1932 x 1932 pixels; Topcon TRC-NW8
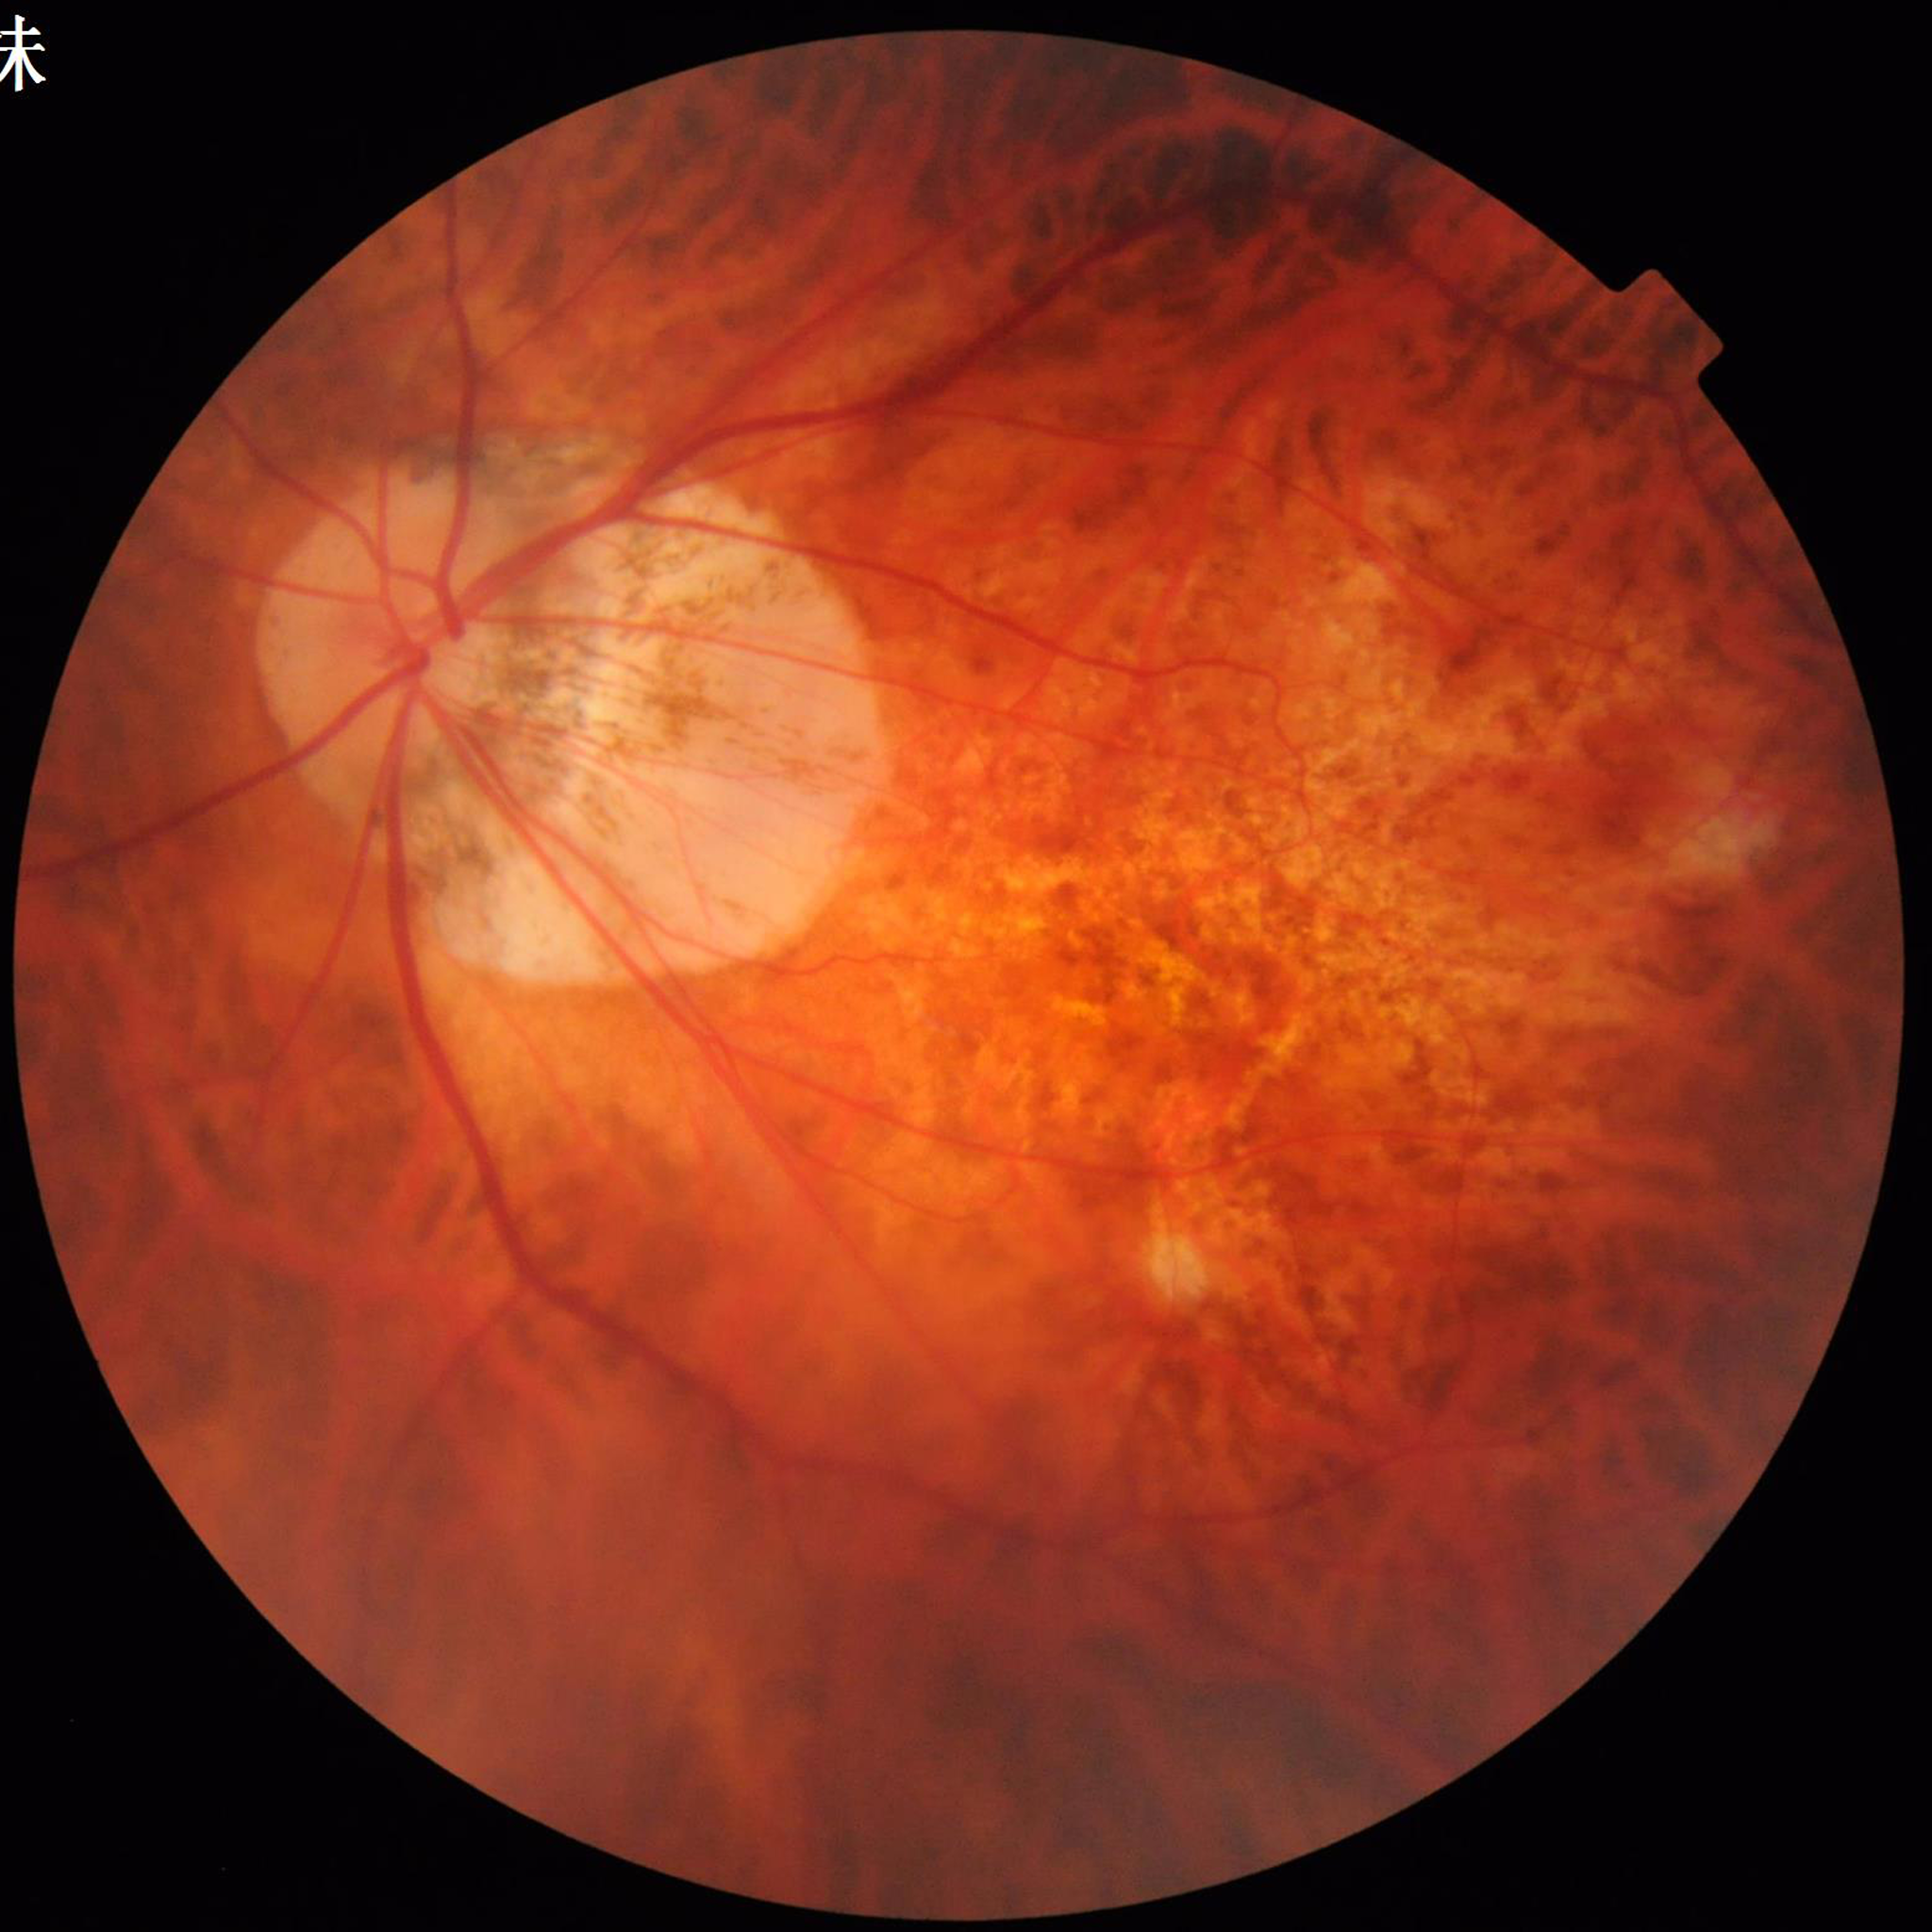
Image quality = adequate | Disease = AMD.